Color fundus image — 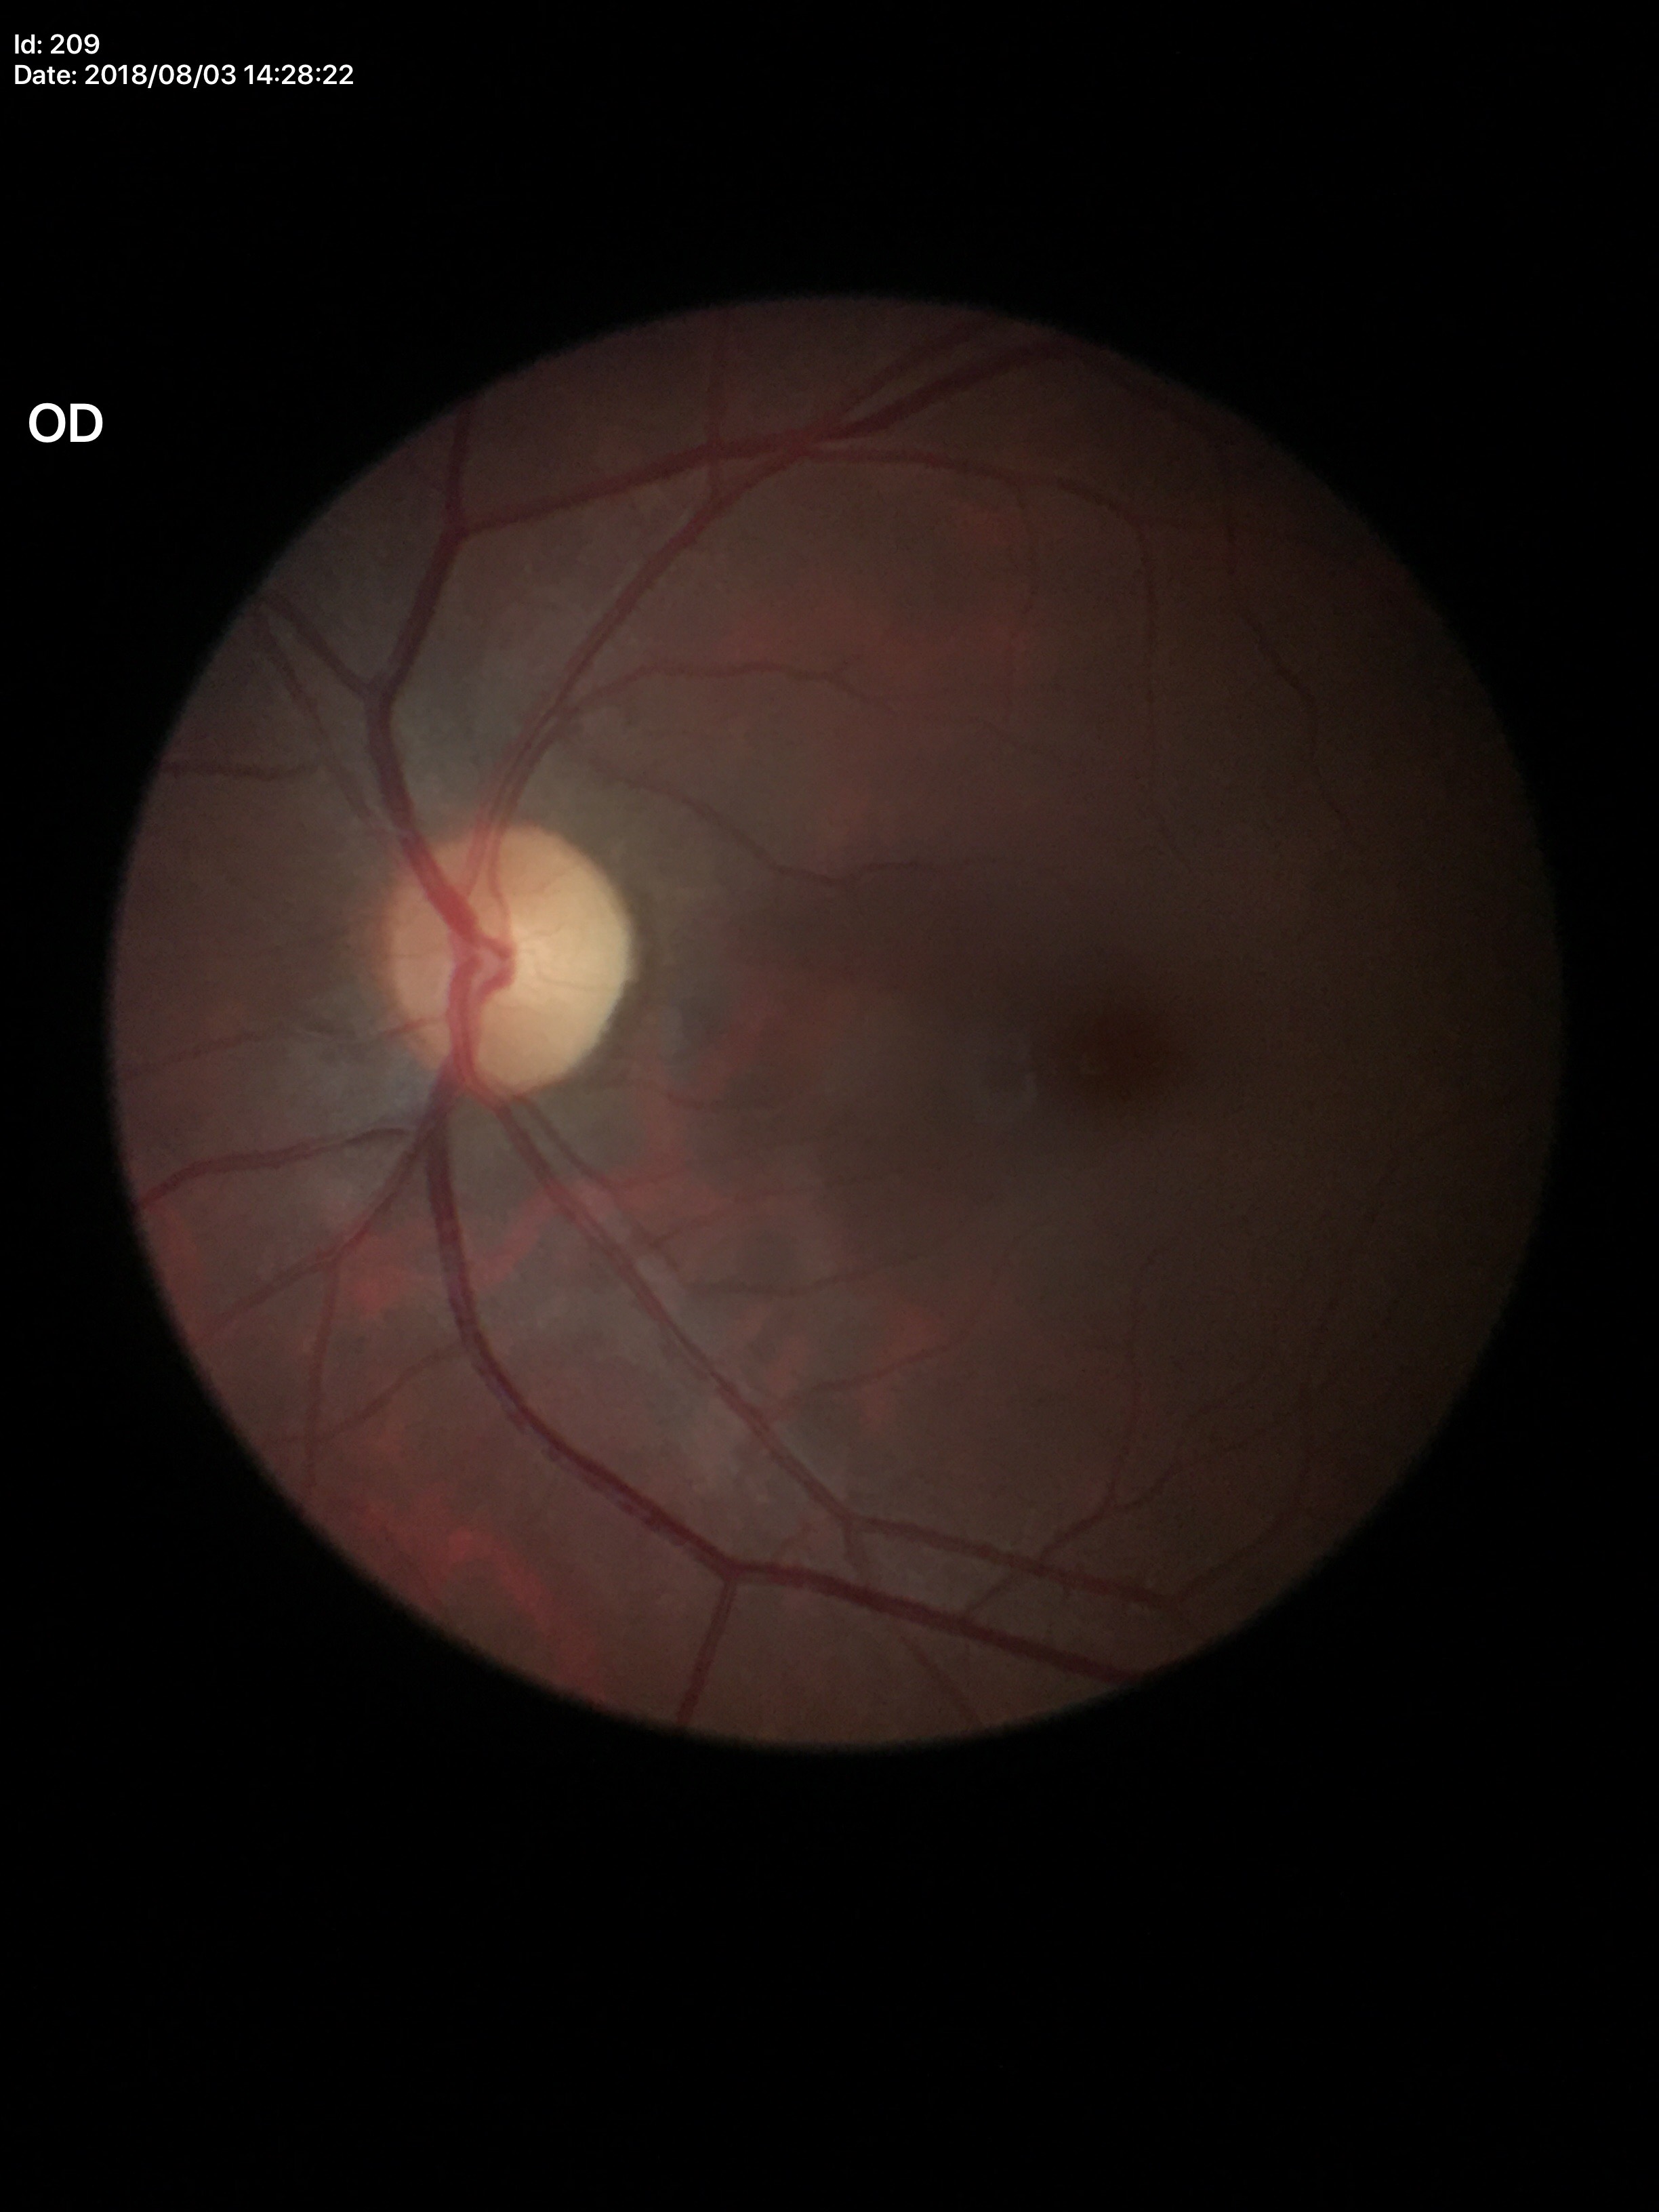 Glaucoma assessment=no suspicious findings | vertical cup-to-disc ratio=0.41